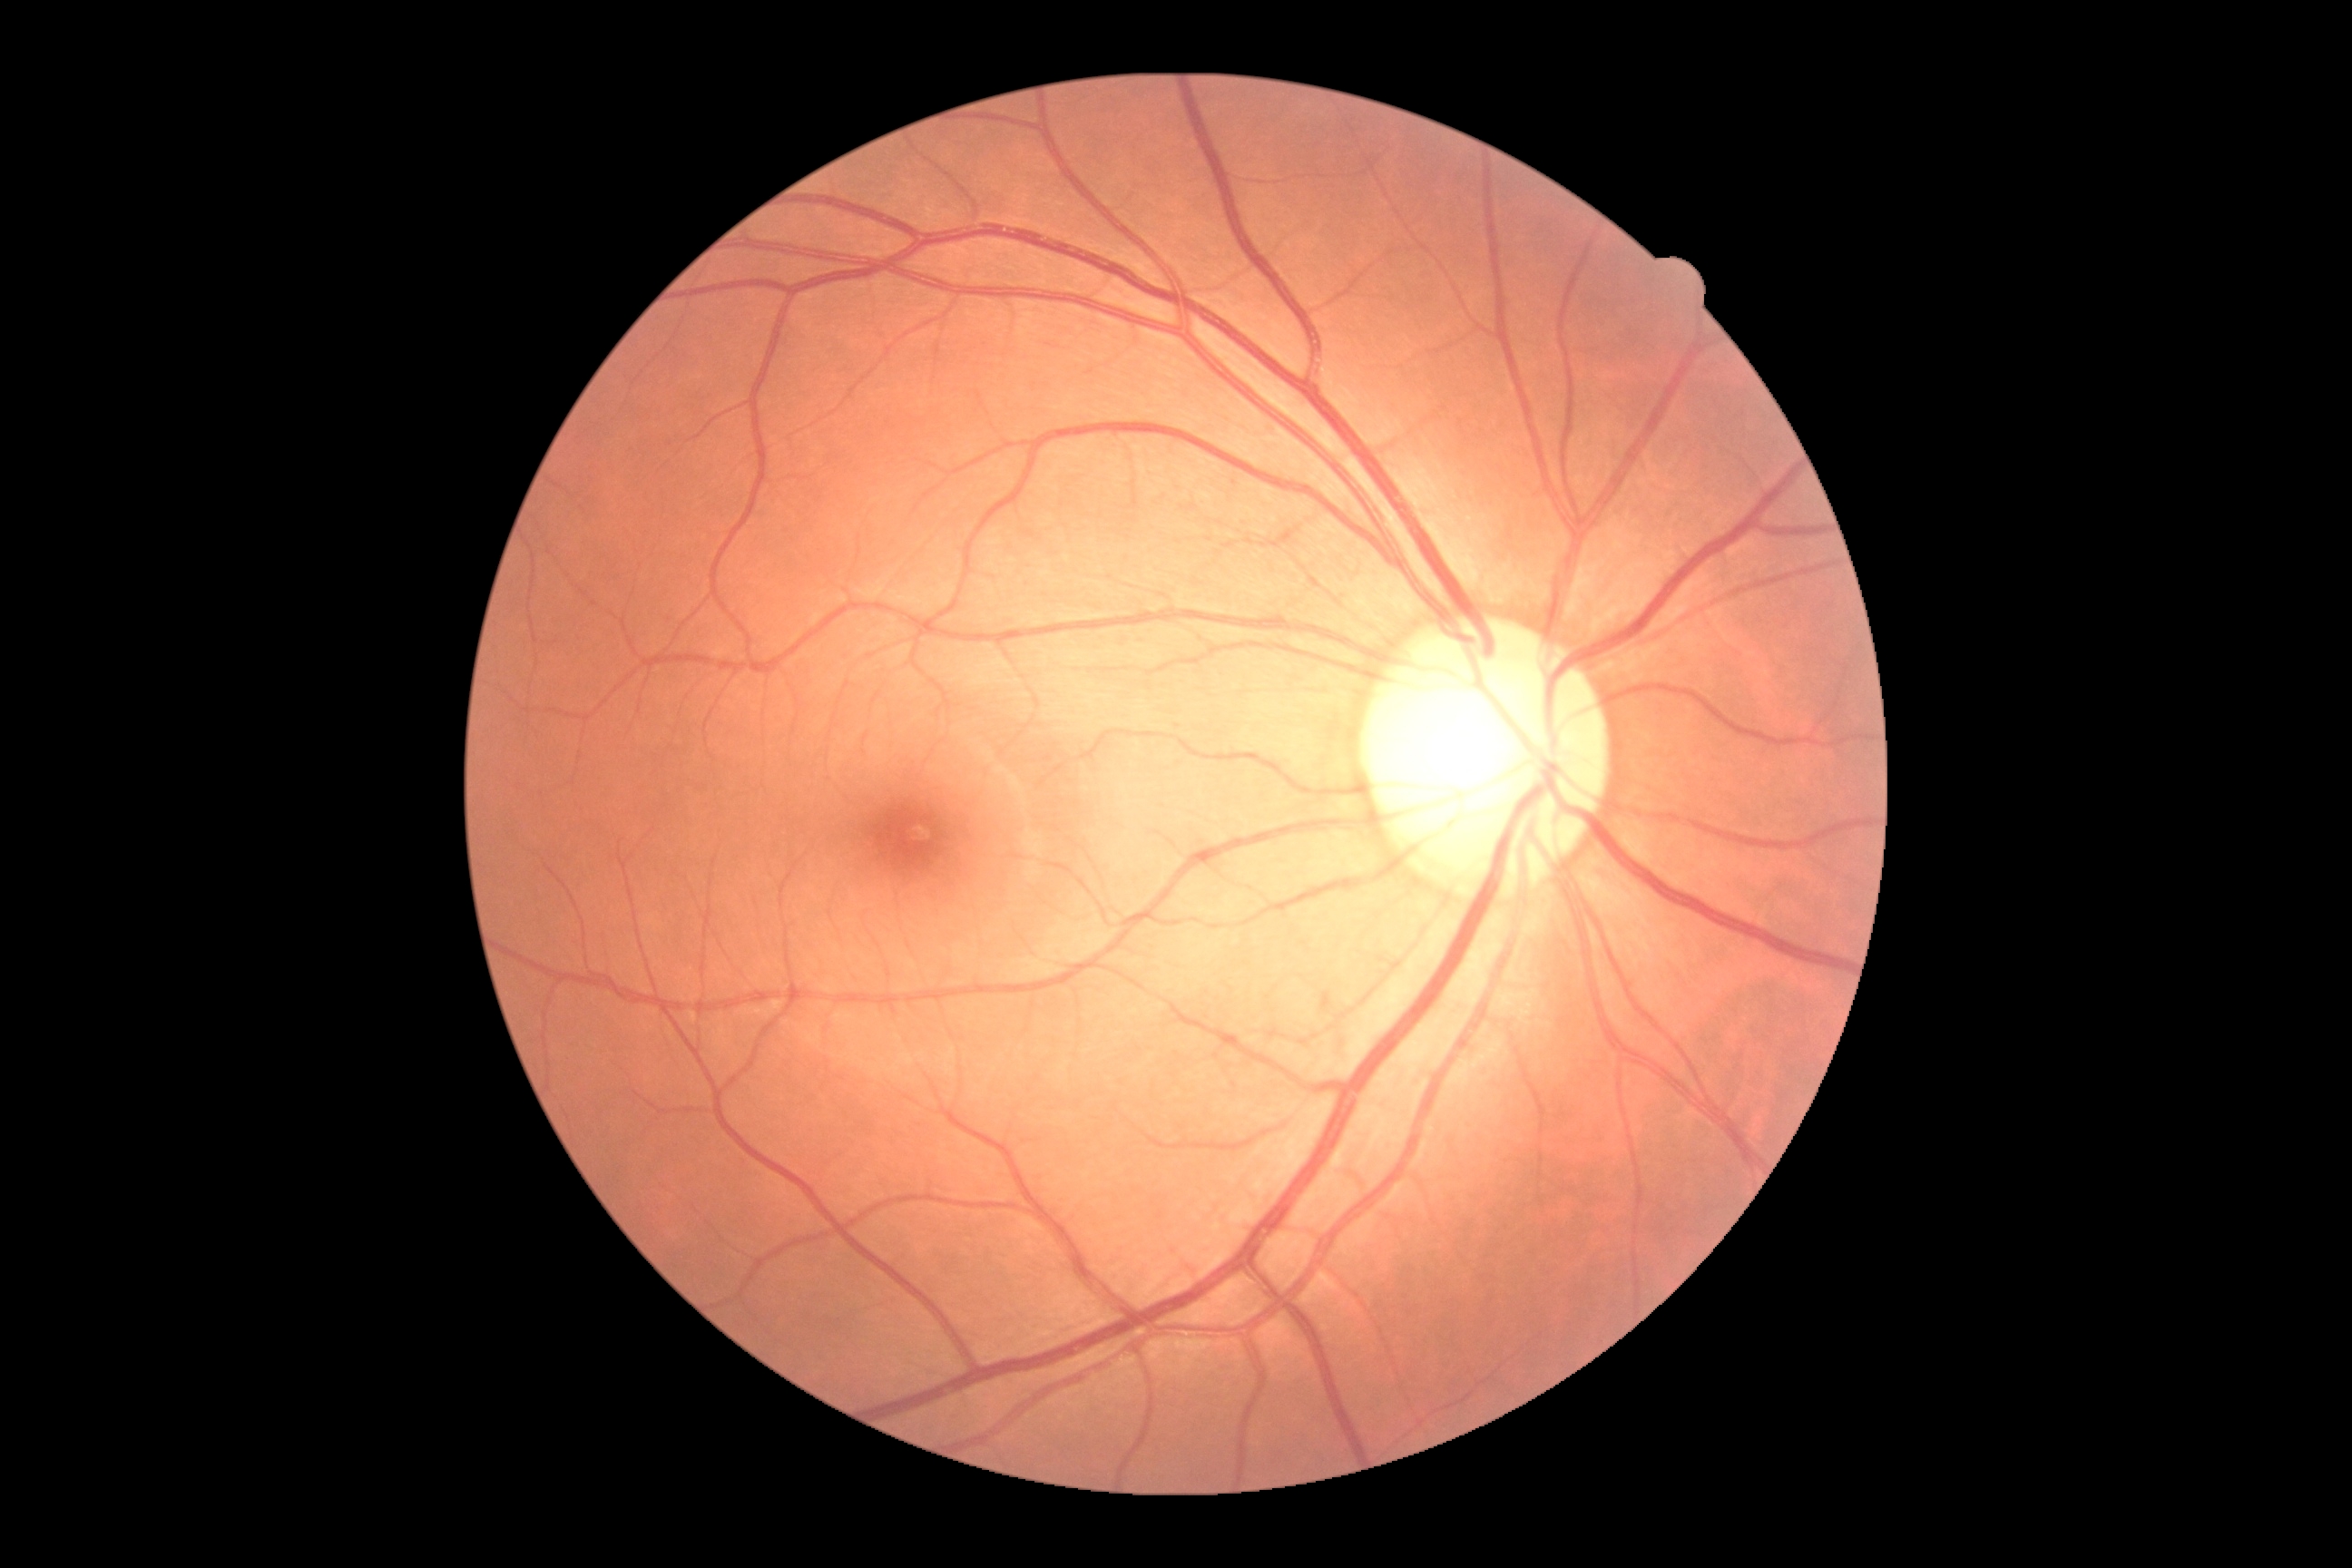
Findings:
• diabetic retinopathy severity: grade 0 (no apparent retinopathy) — no visible signs of diabetic retinopathy